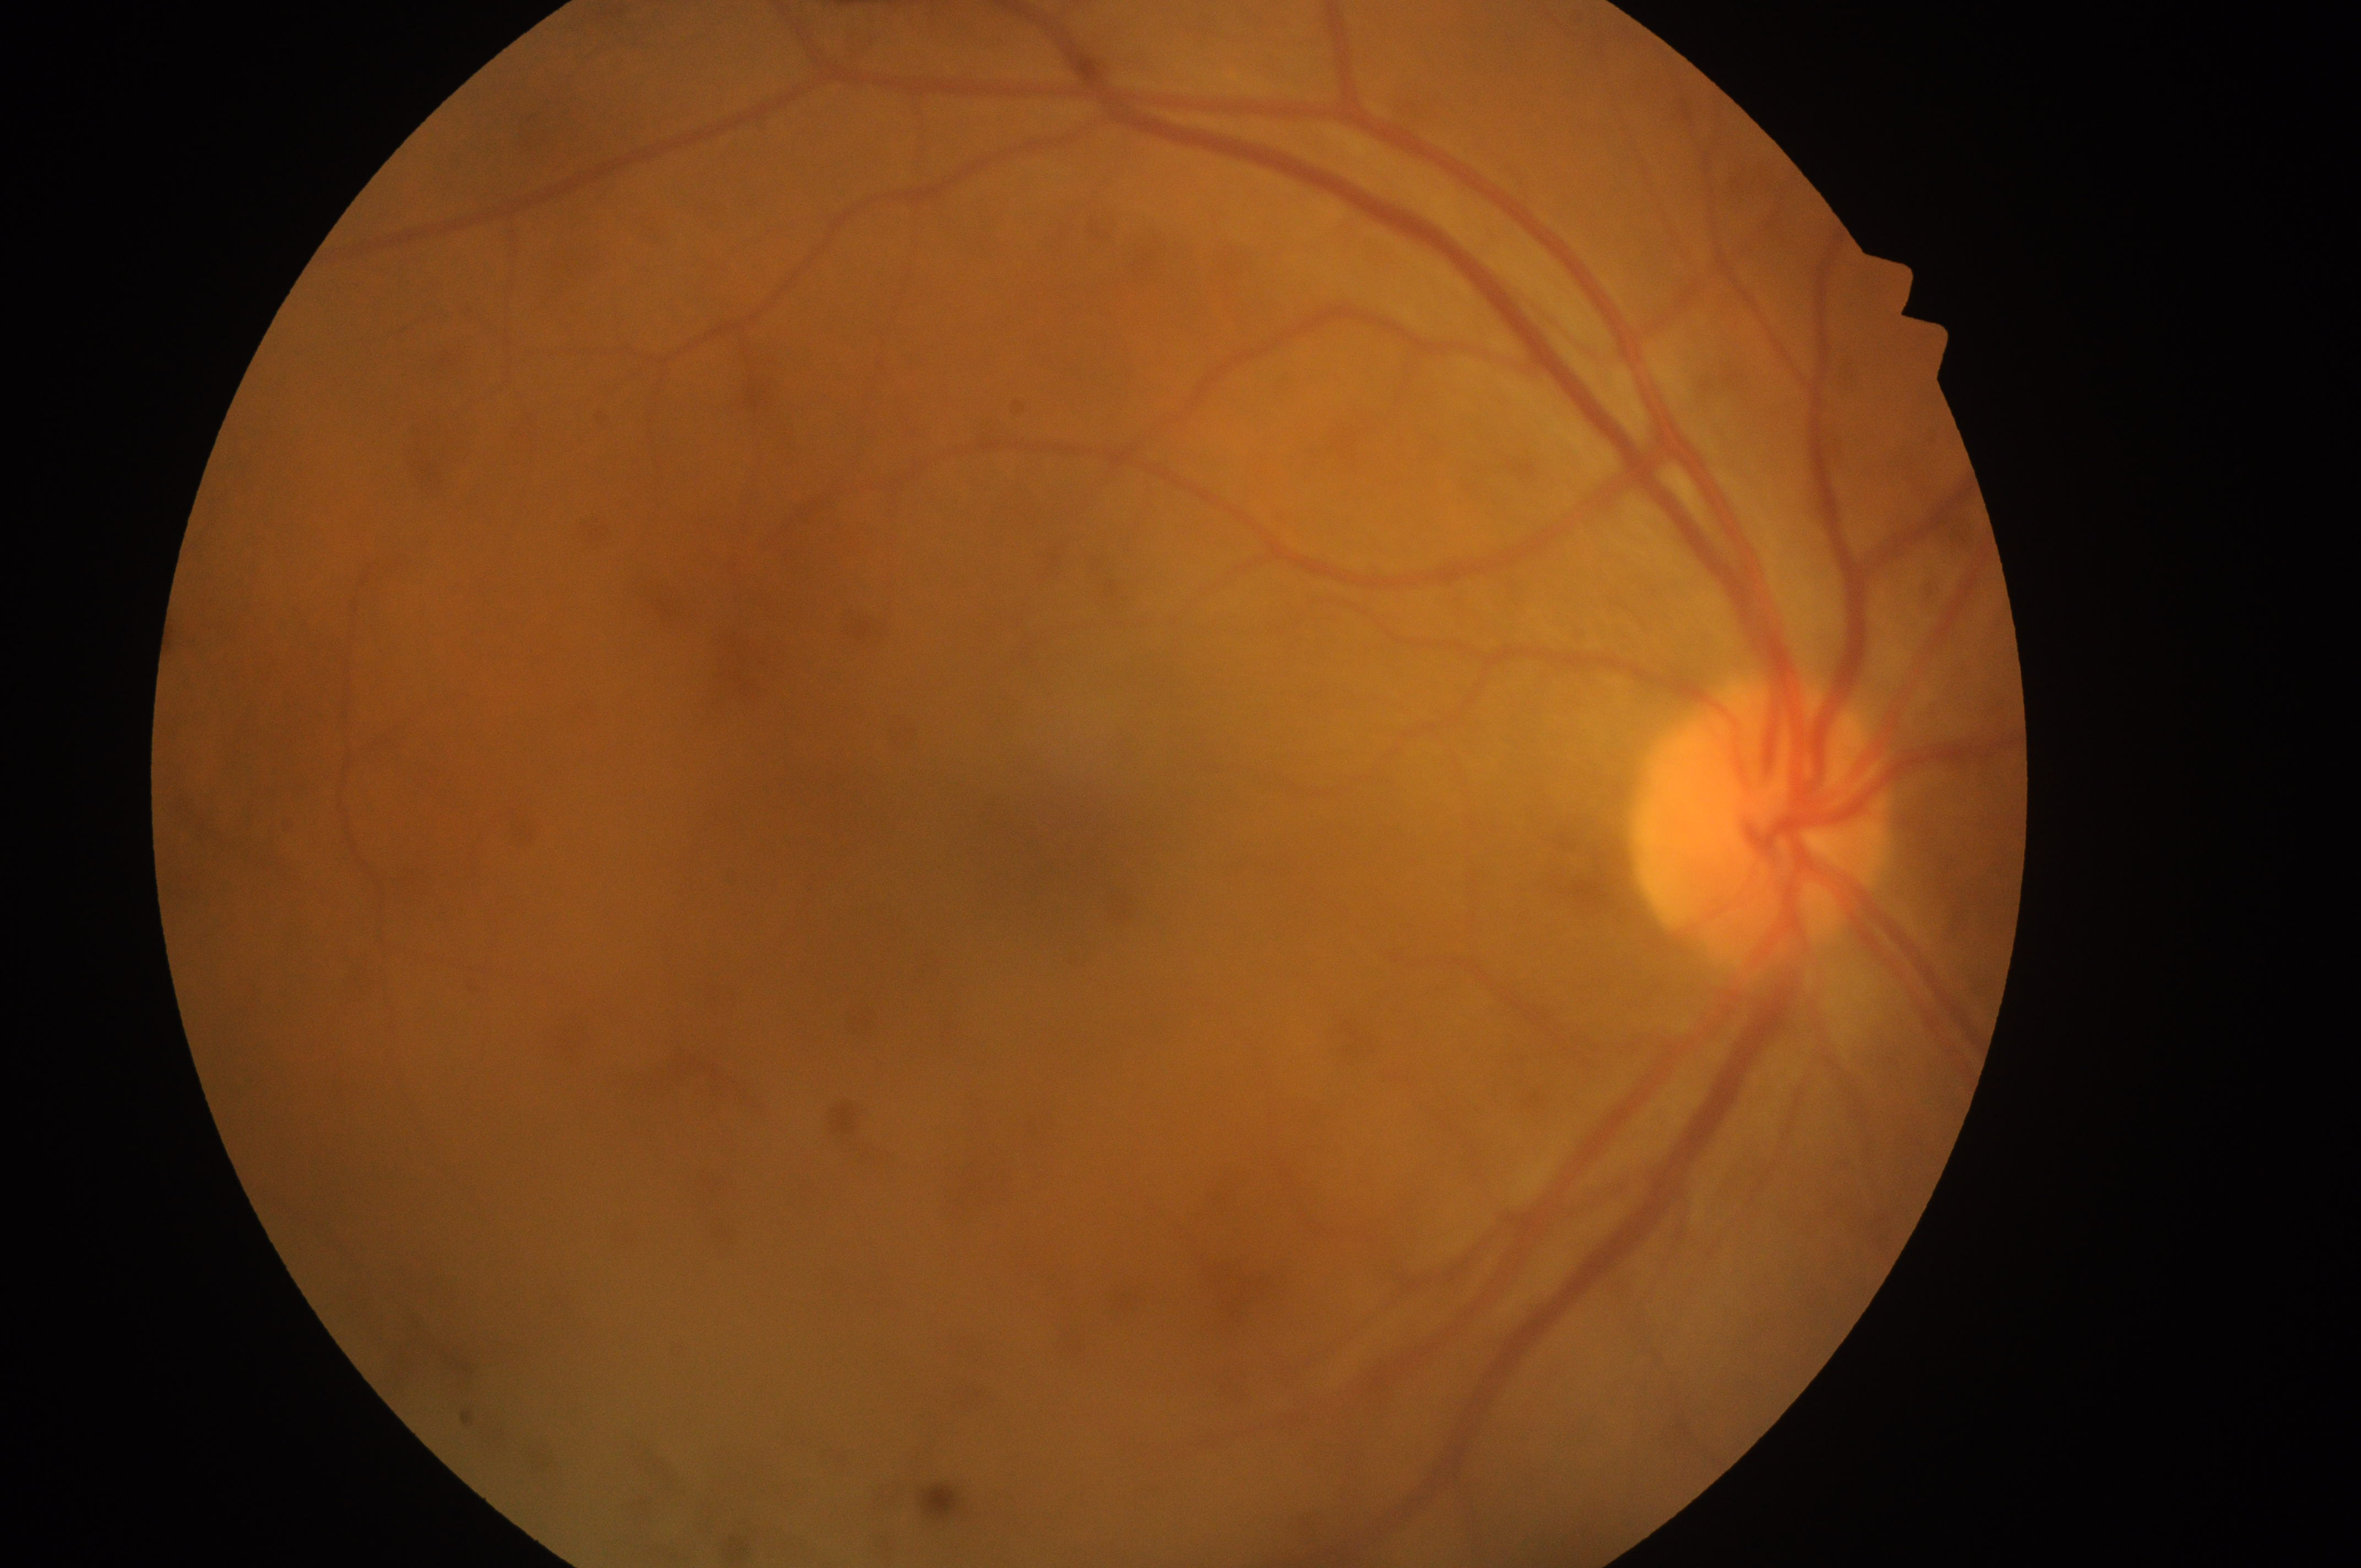
Diabetic retinopathy (DR) is no apparent diabetic retinopathy (grade 0).
Fovea centralis located at (1056, 858).
The image shows the oculus dexter.
The optic nerve head is at (1755, 837).
Diabetic macular edema (DME): no risk (grade 0).